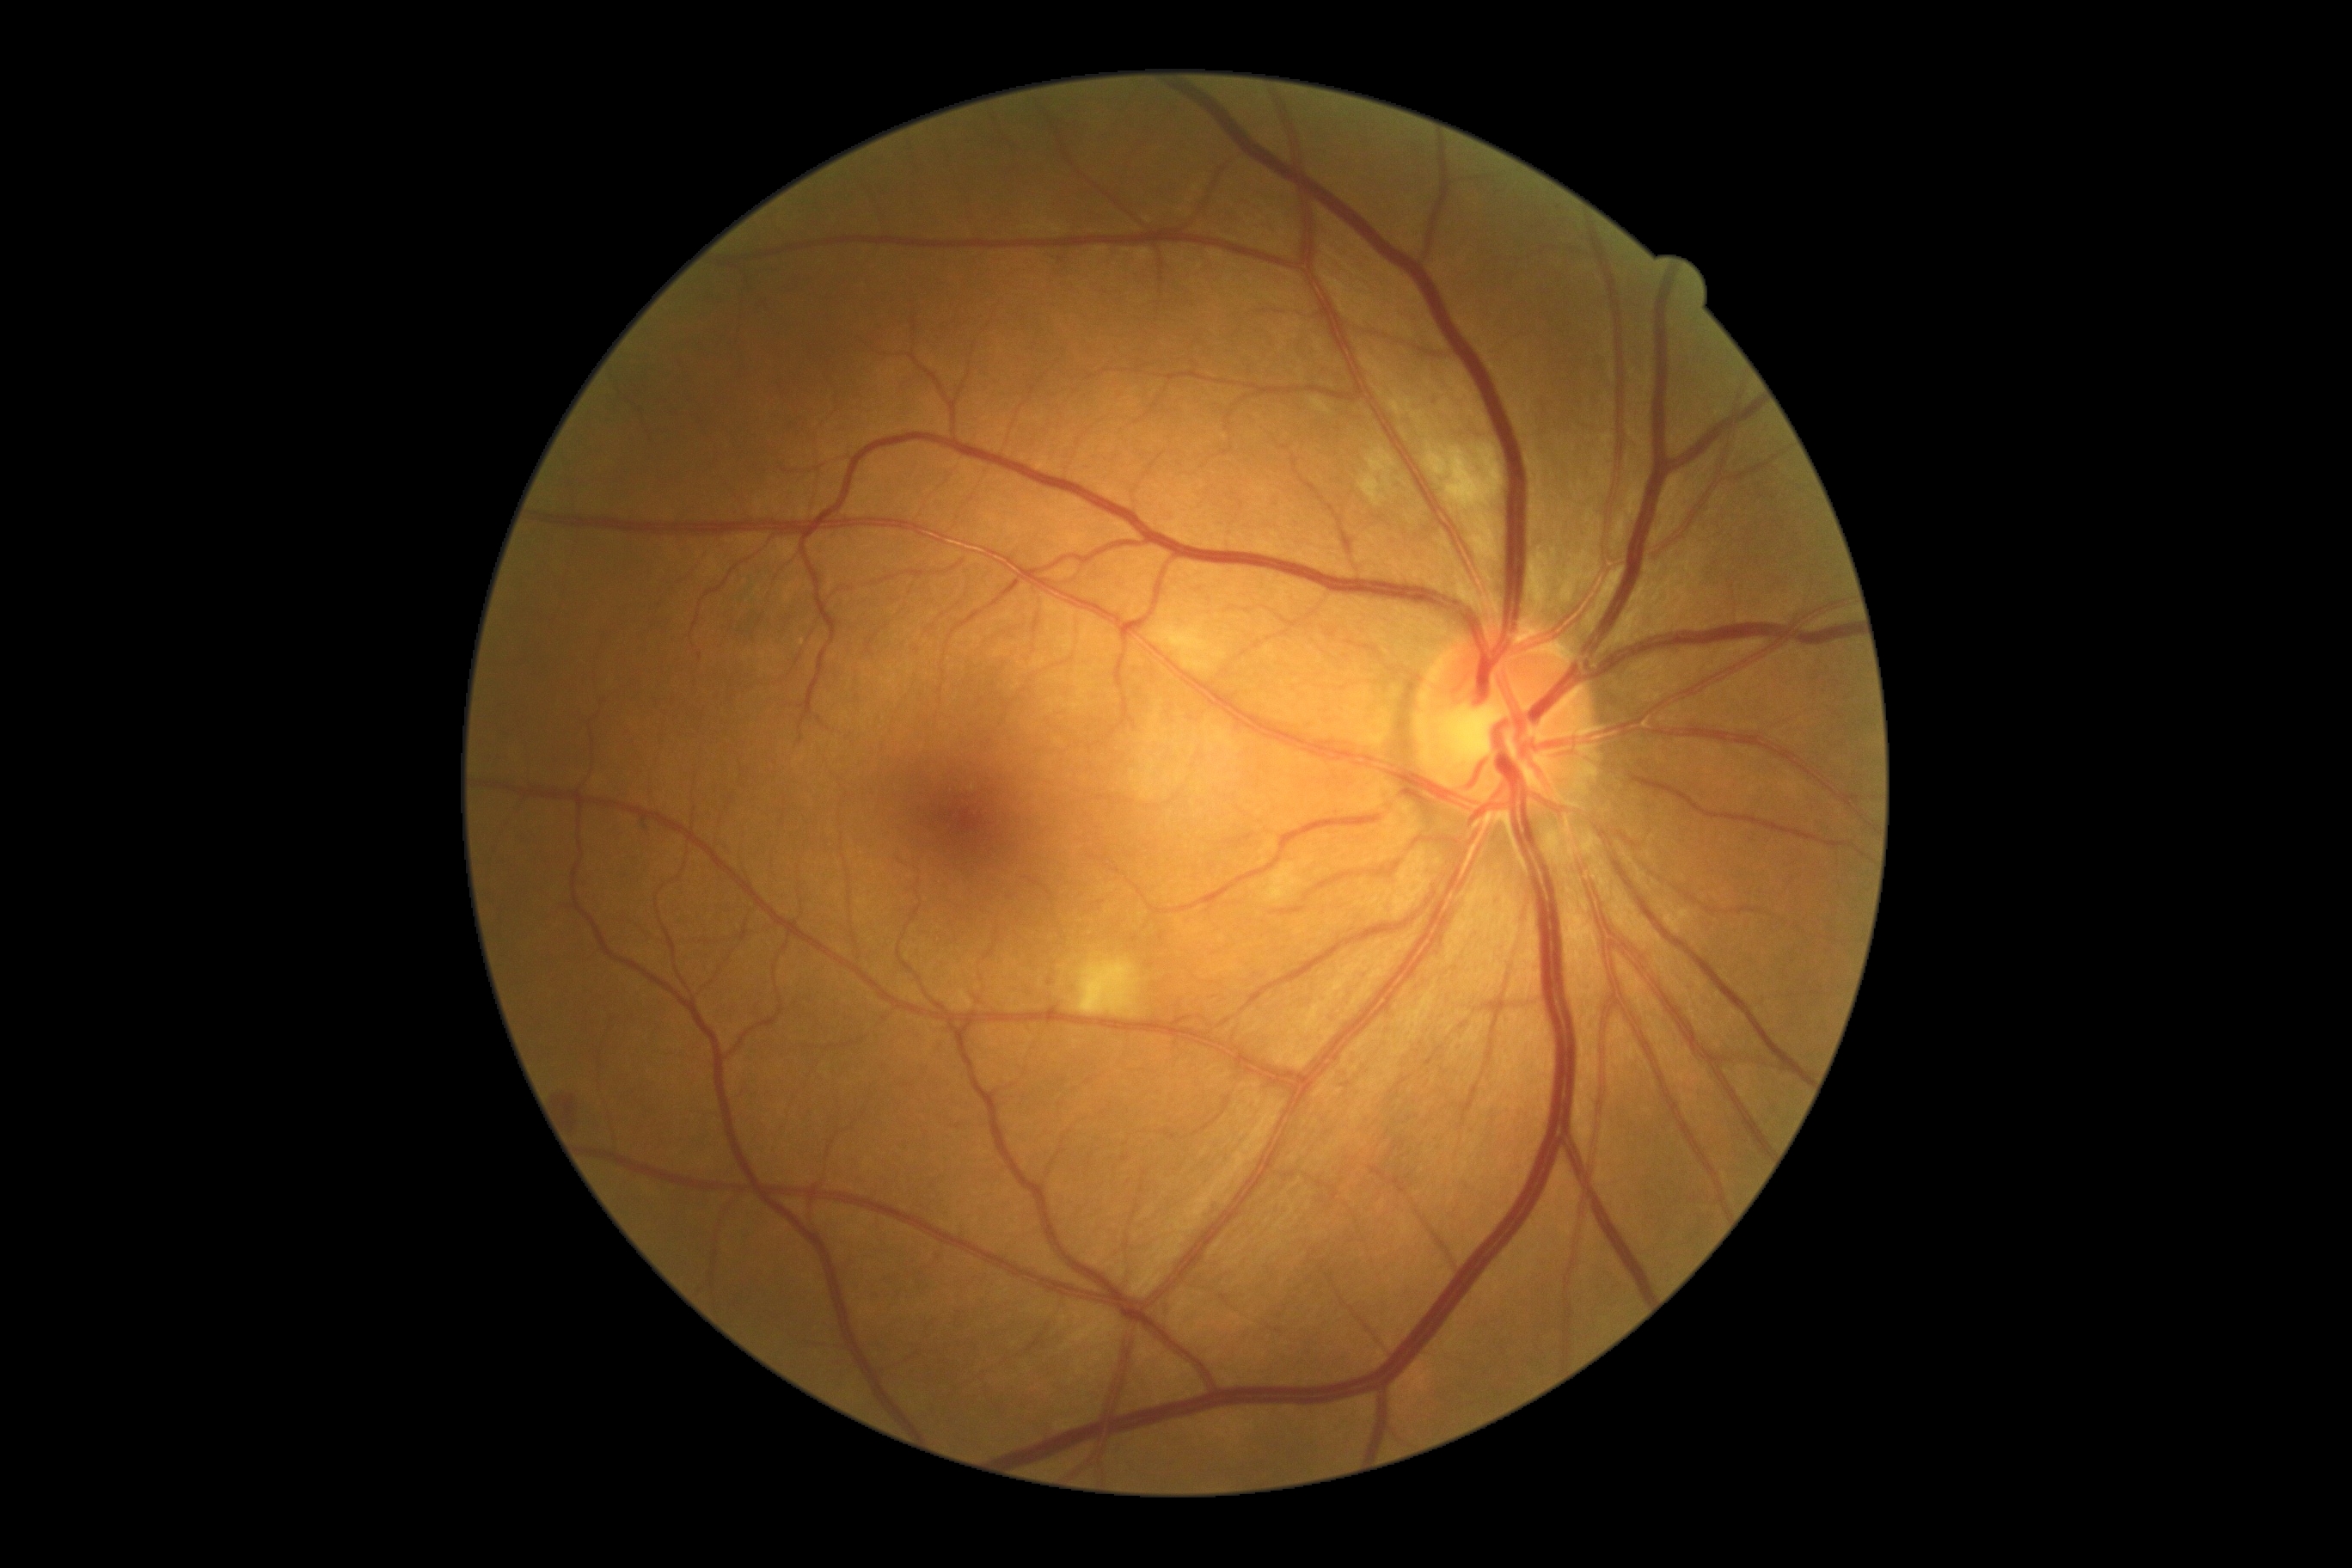
DR stage: grade 2
DR class: non-proliferative diabetic retinopathy